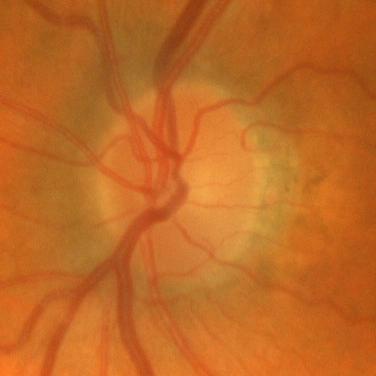
Consistent with no evidence of glaucoma.